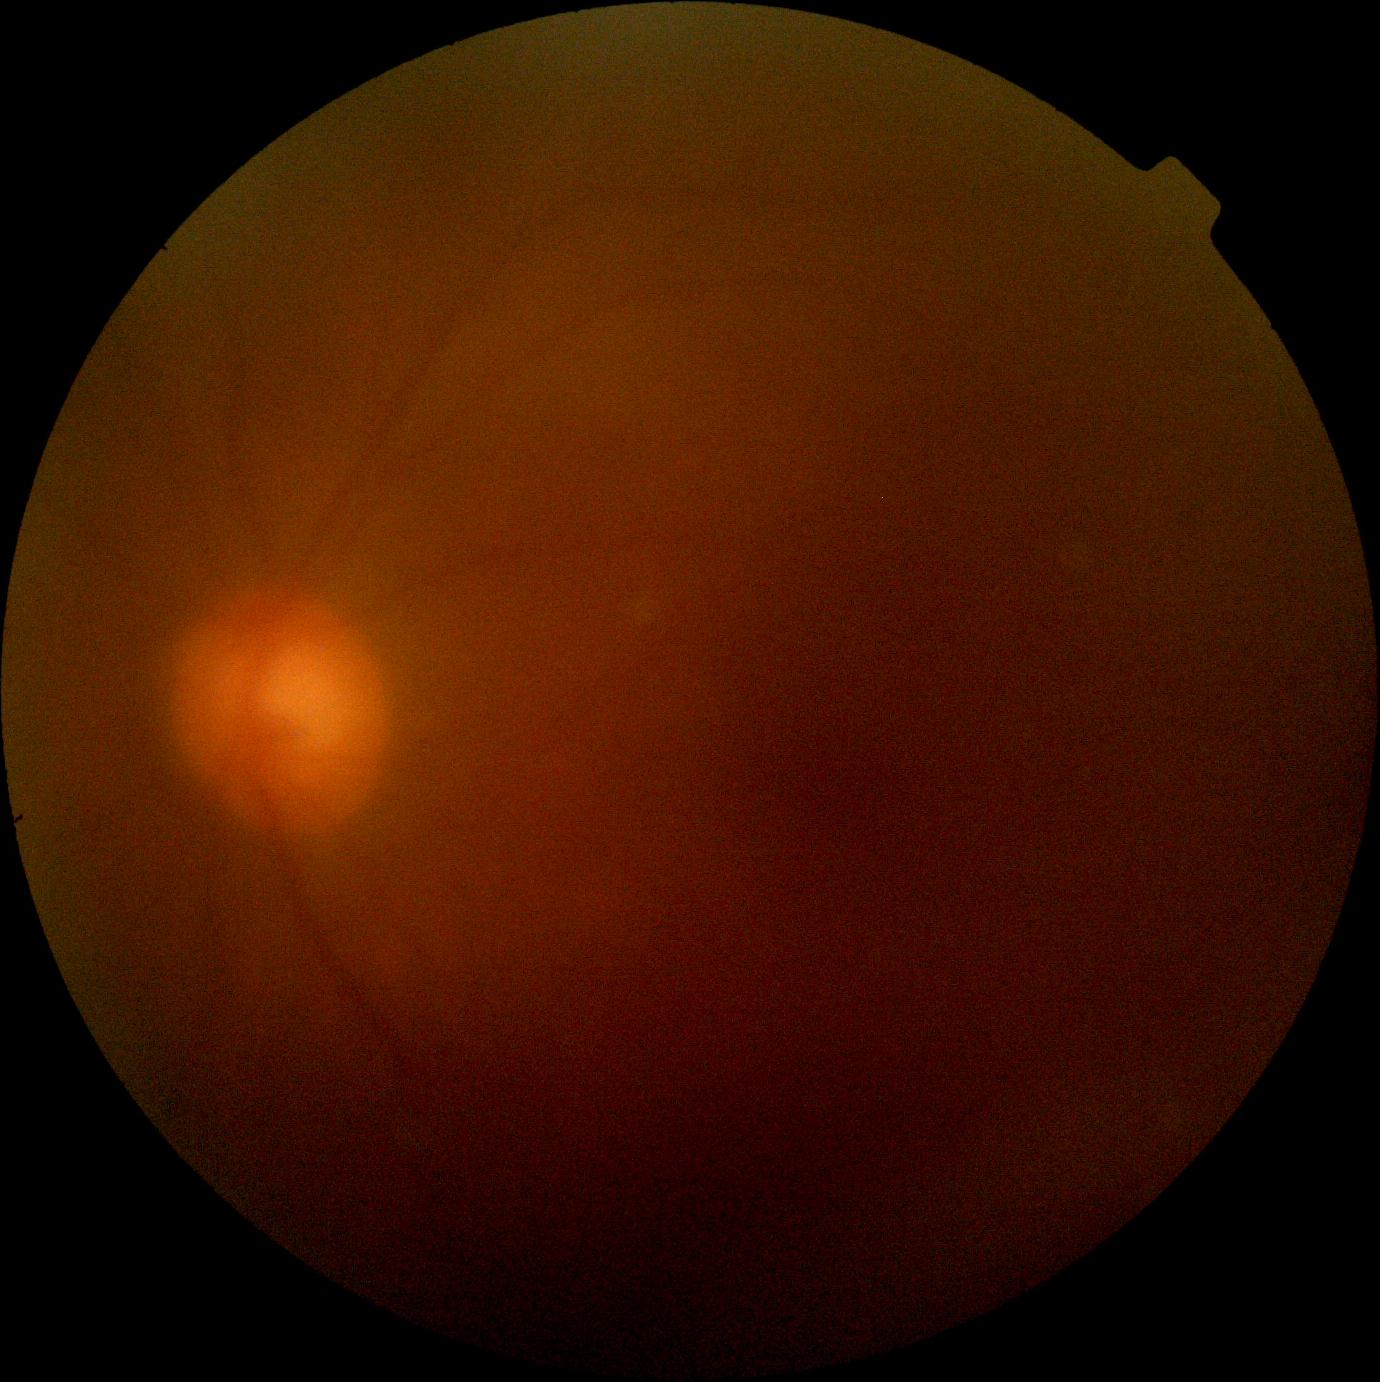
Quality too poor to assess for DR.
DR stage is ungradable.